1240x1240. Wide-field fundus image from infant ROP screening. 100° field of view (Phoenix ICON)
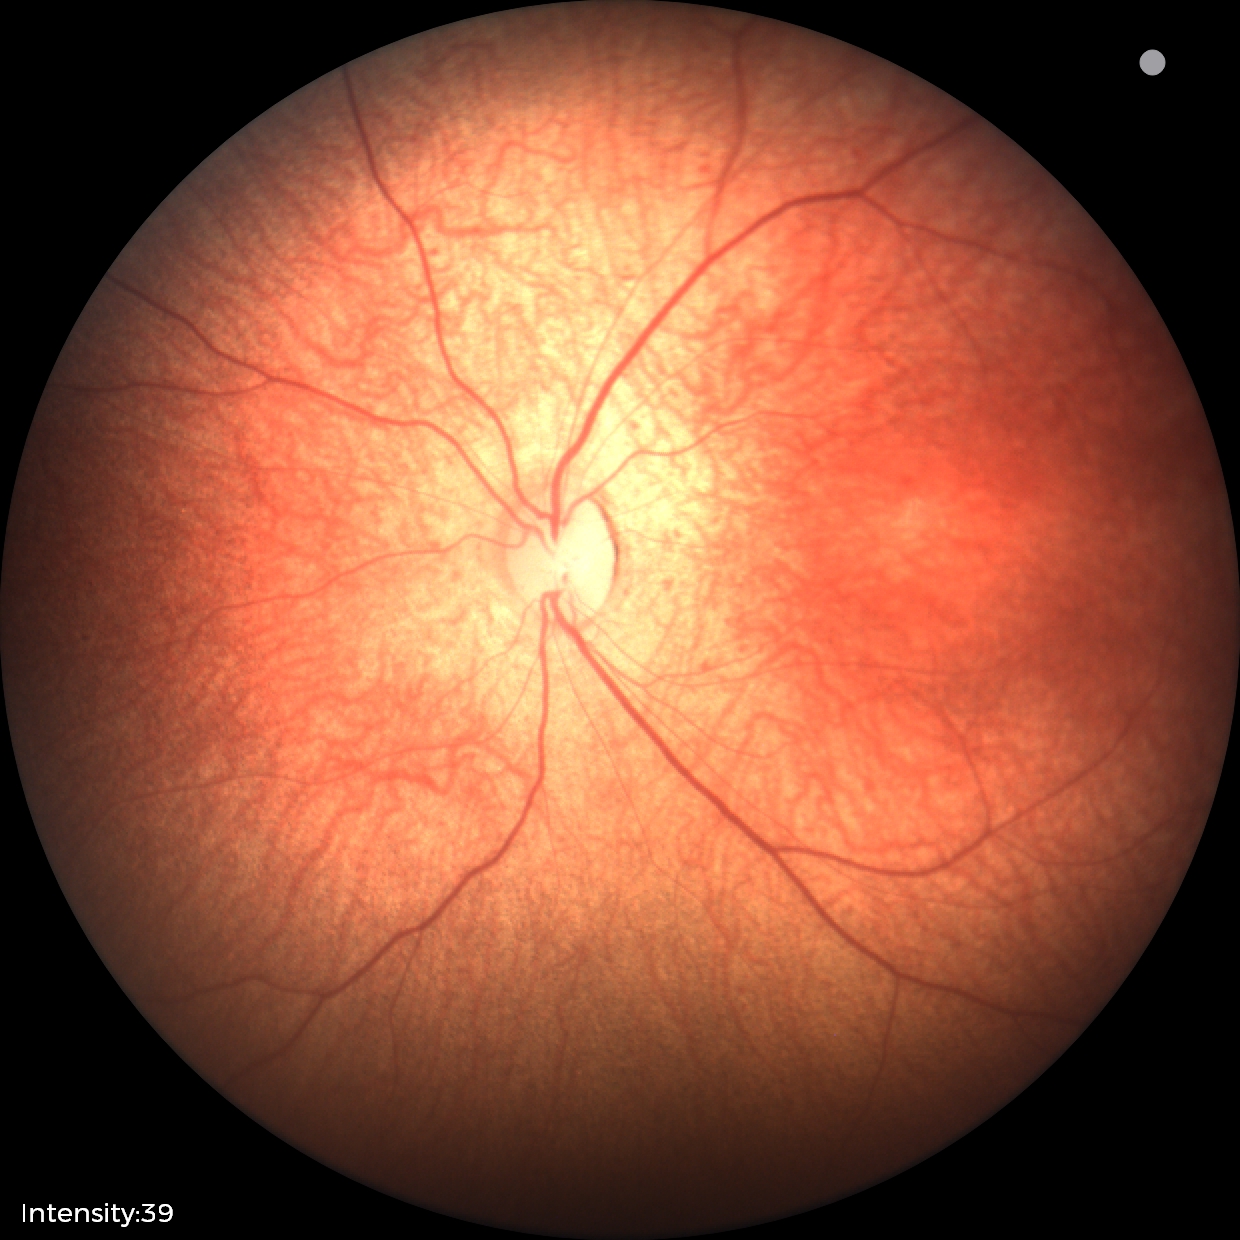
Diagnosis: normal retinal appearance